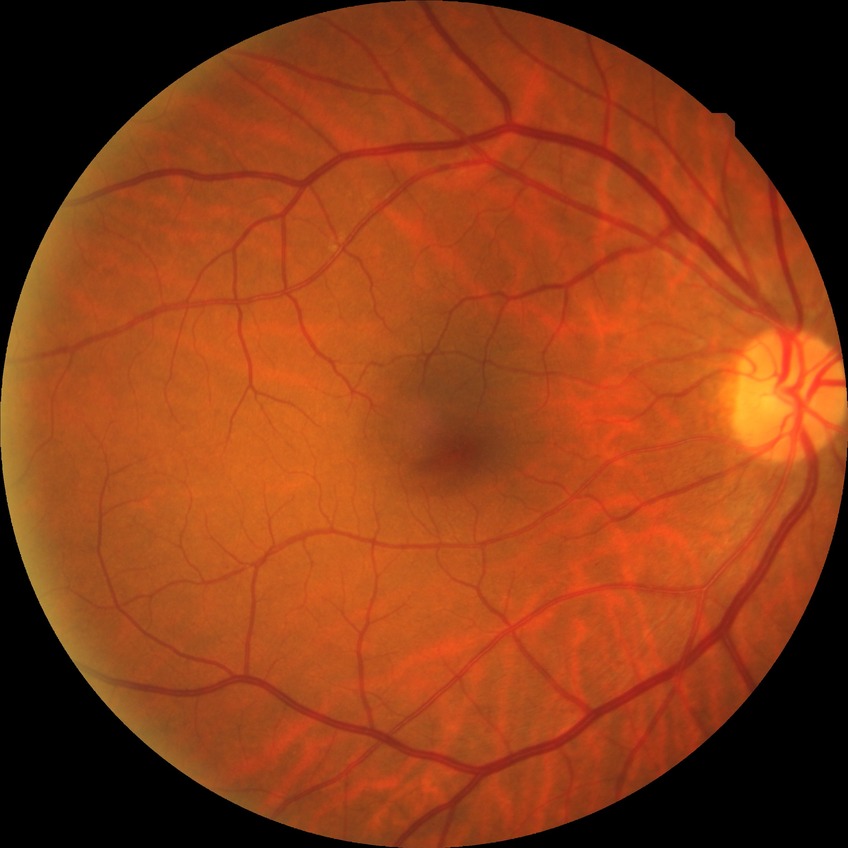

DR grade is NDR.